CFP.
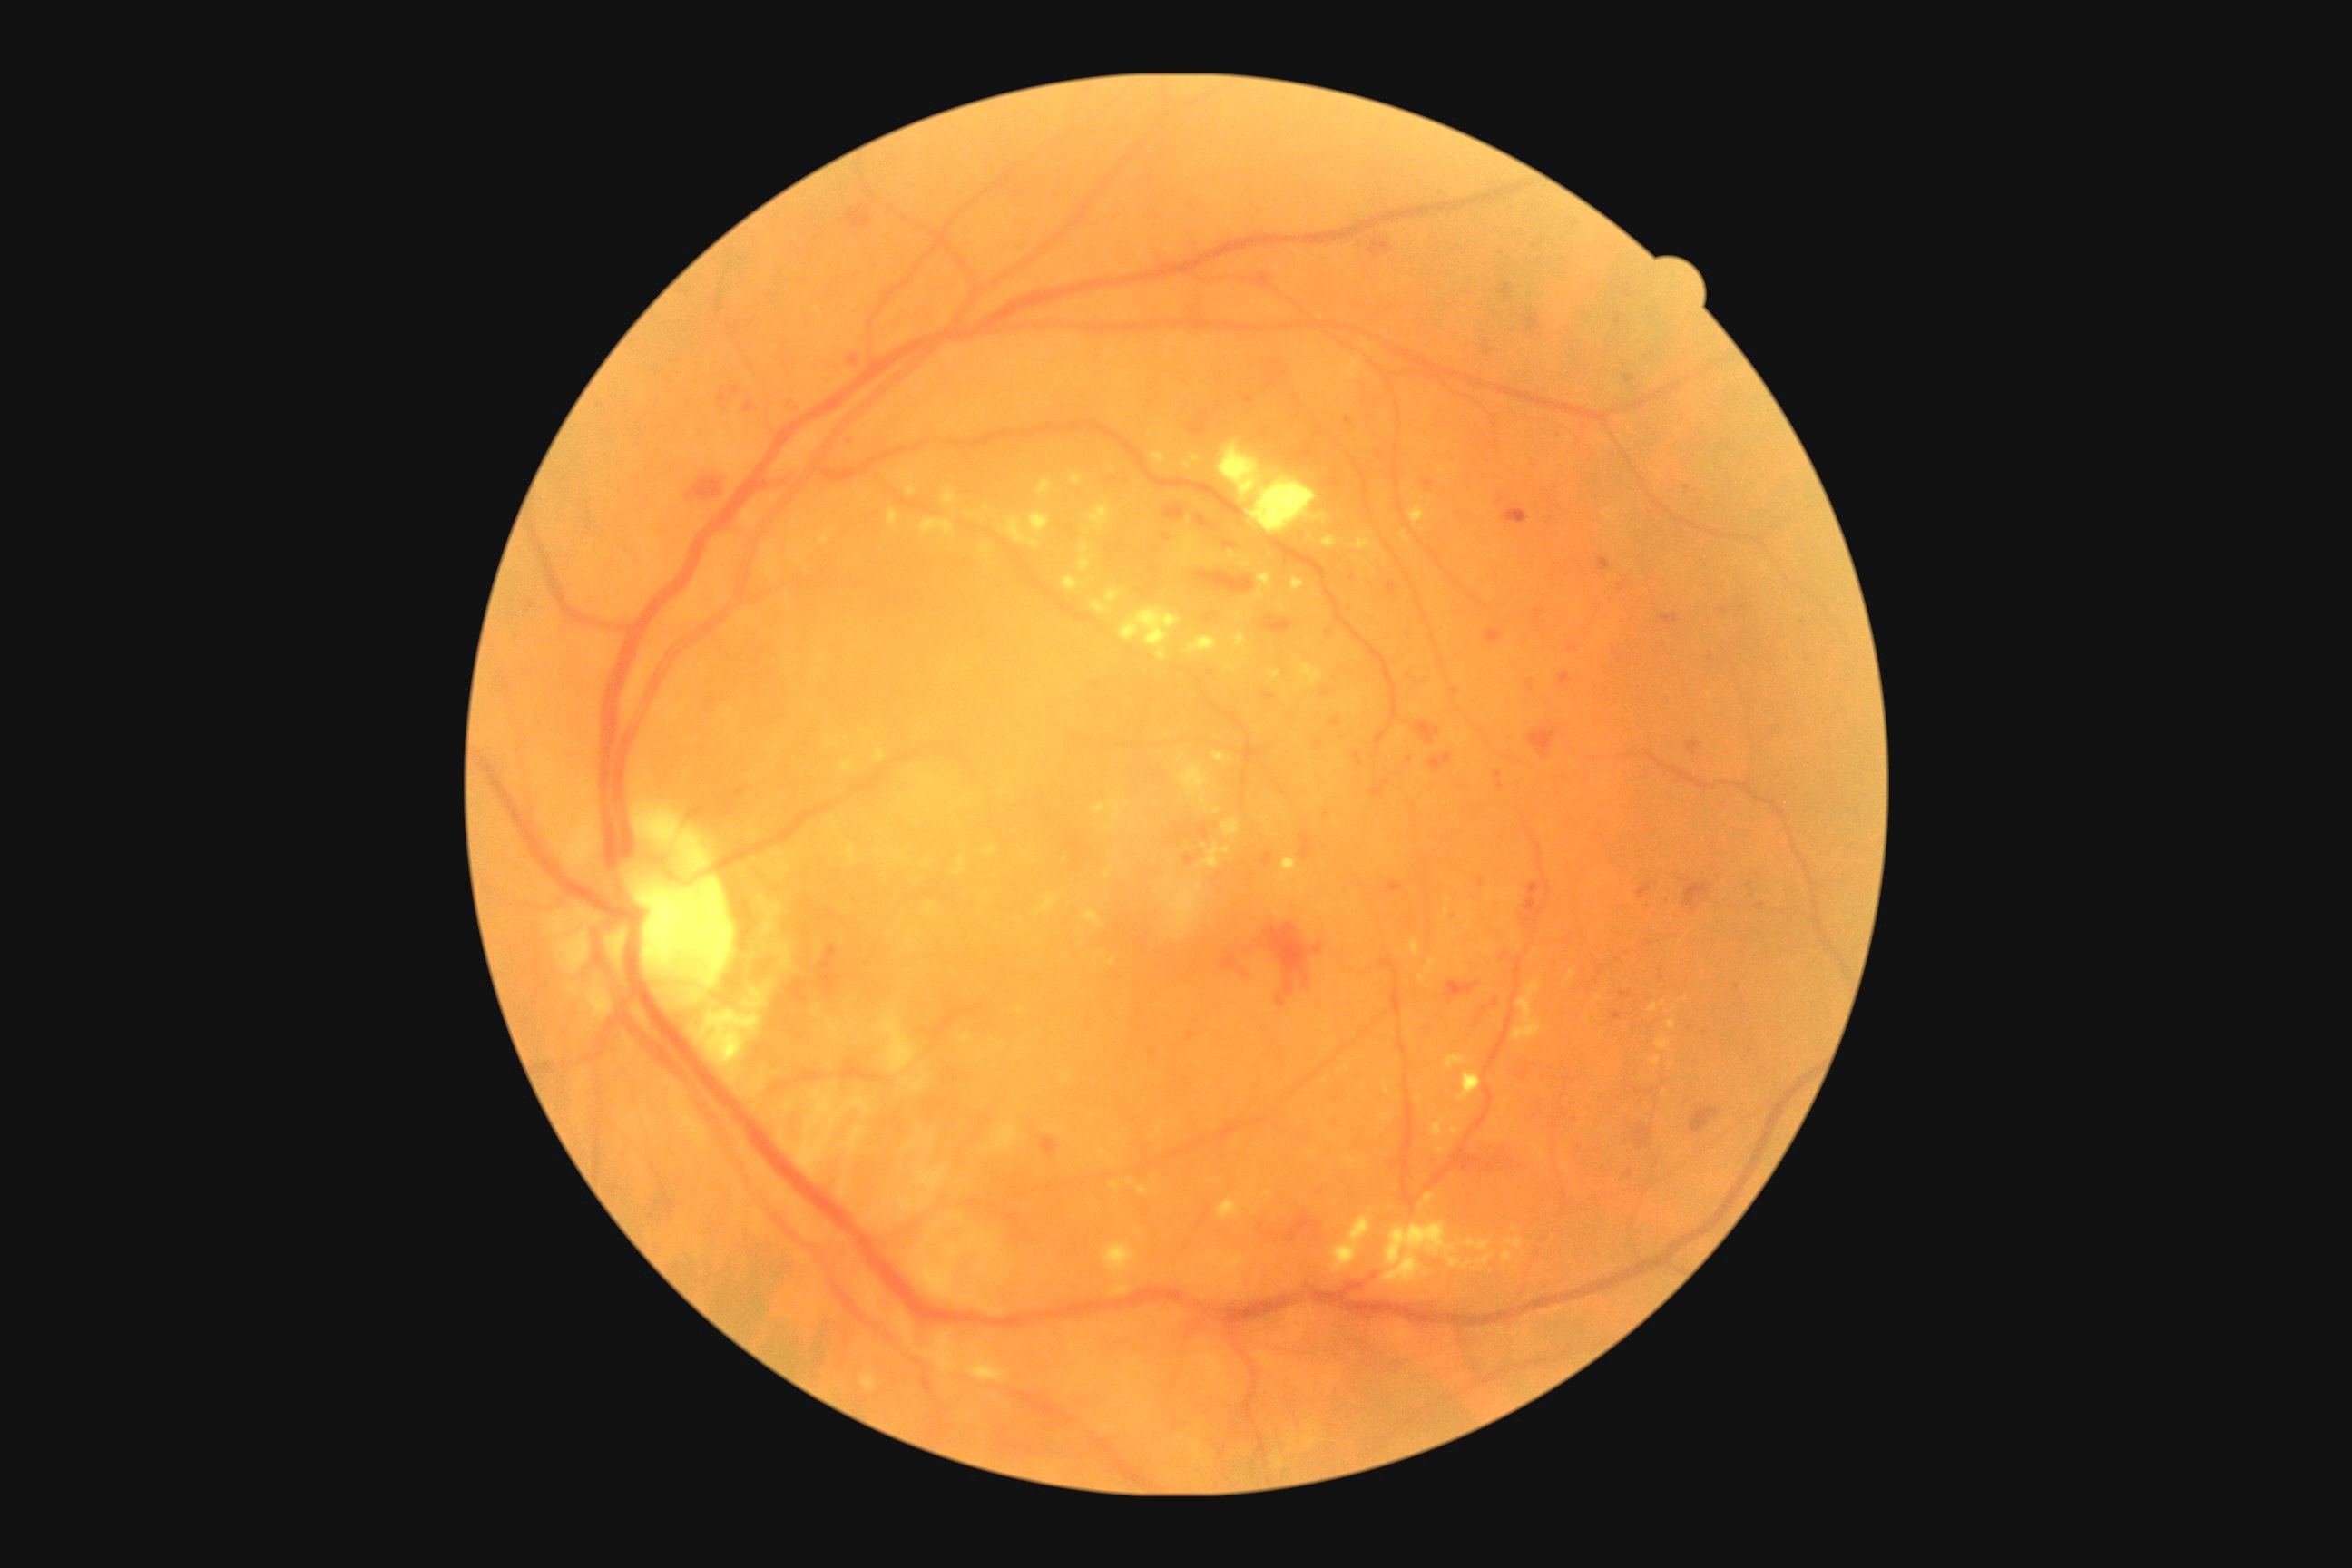 DR grade: 3/4. DR class: non-proliferative diabetic retinopathy.